Infant wide-field retinal image; 1240 x 1240 pixels.
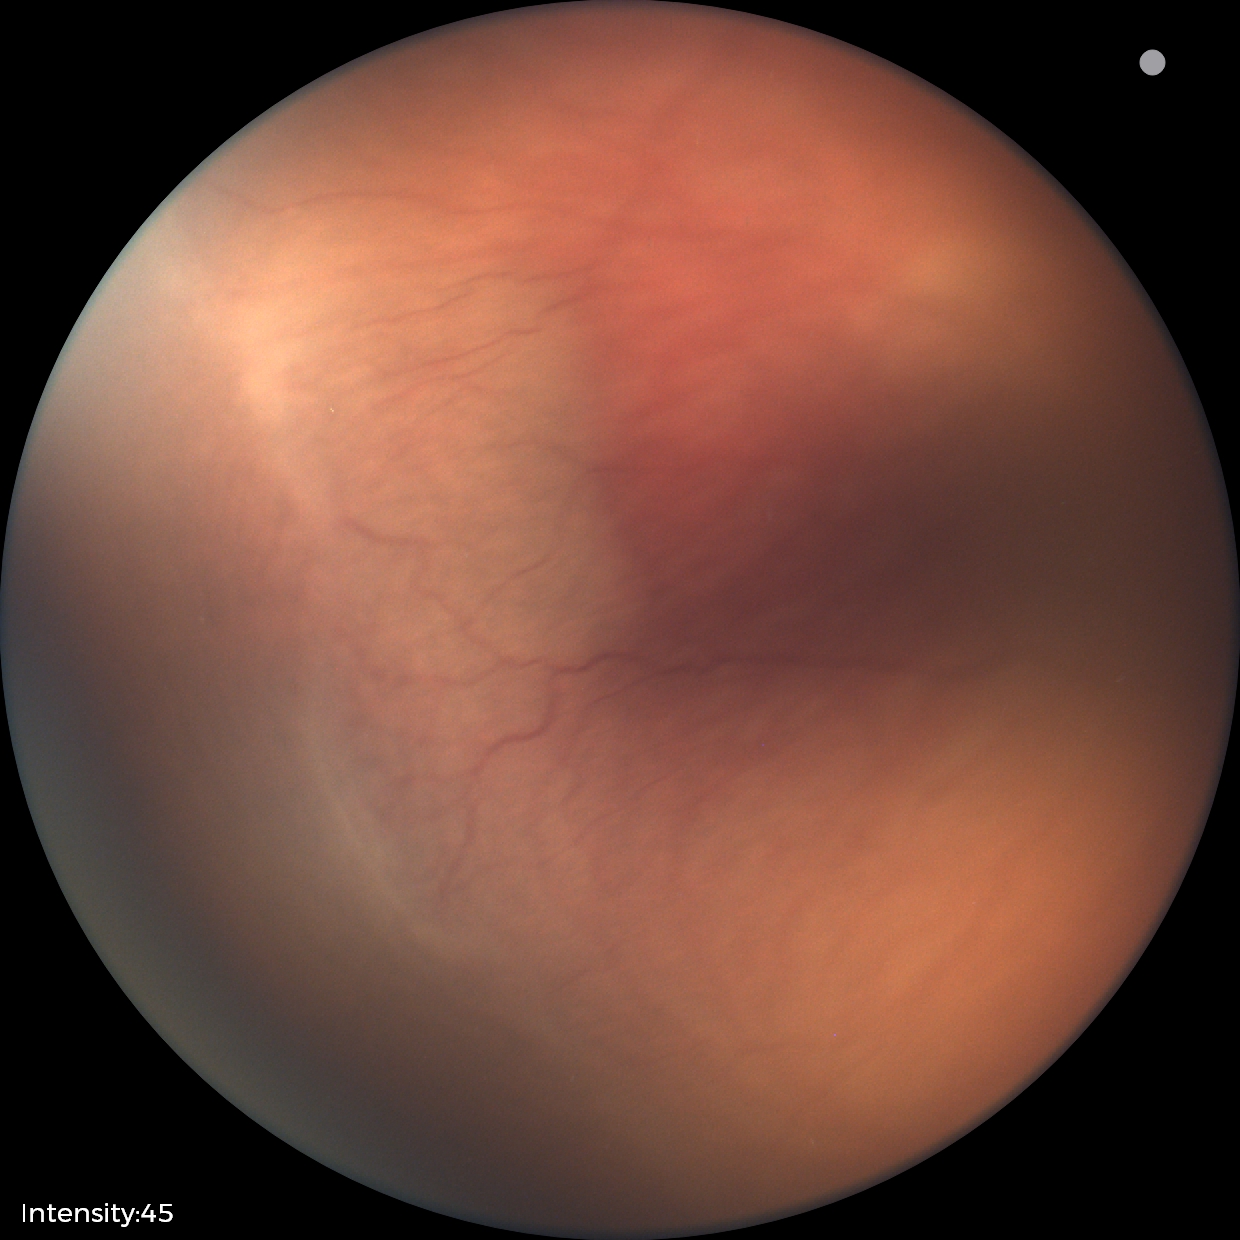 Diagnosis = ROP stage 2 — ridge with height and width at the demarcation line
plus disease = absent — posterior pole vessels without abnormal dilation or tortuosity